848 x 848 pixels, modified Davis grading, acquired with a NIDEK AFC-230 — 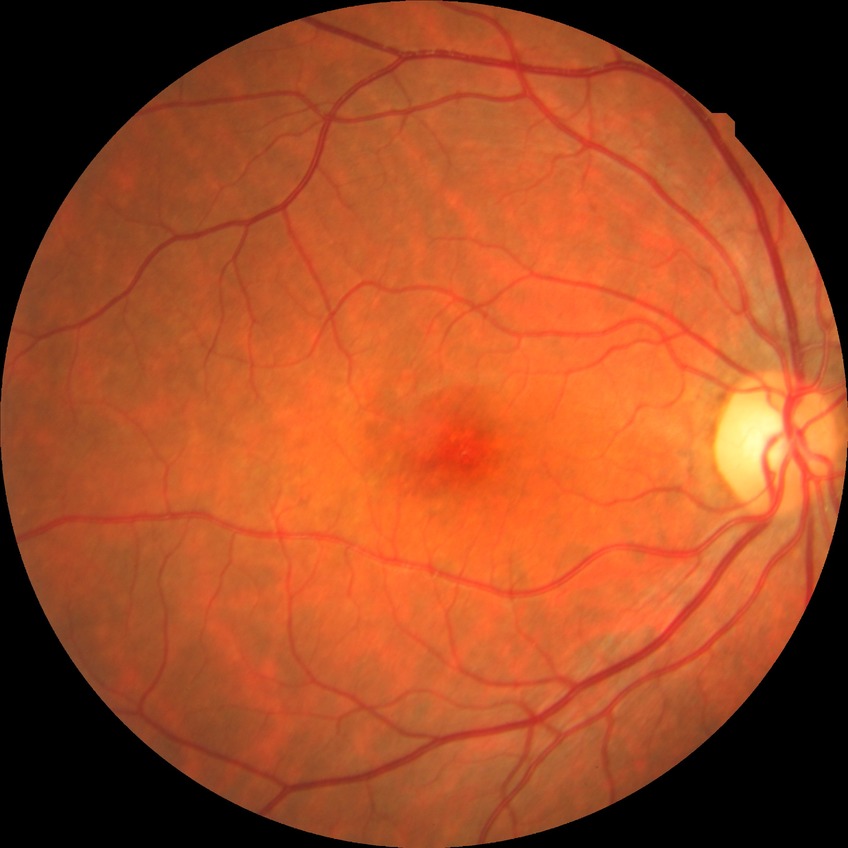

davis_grade: NDR (no diabetic retinopathy)